2048 x 1536 pixels
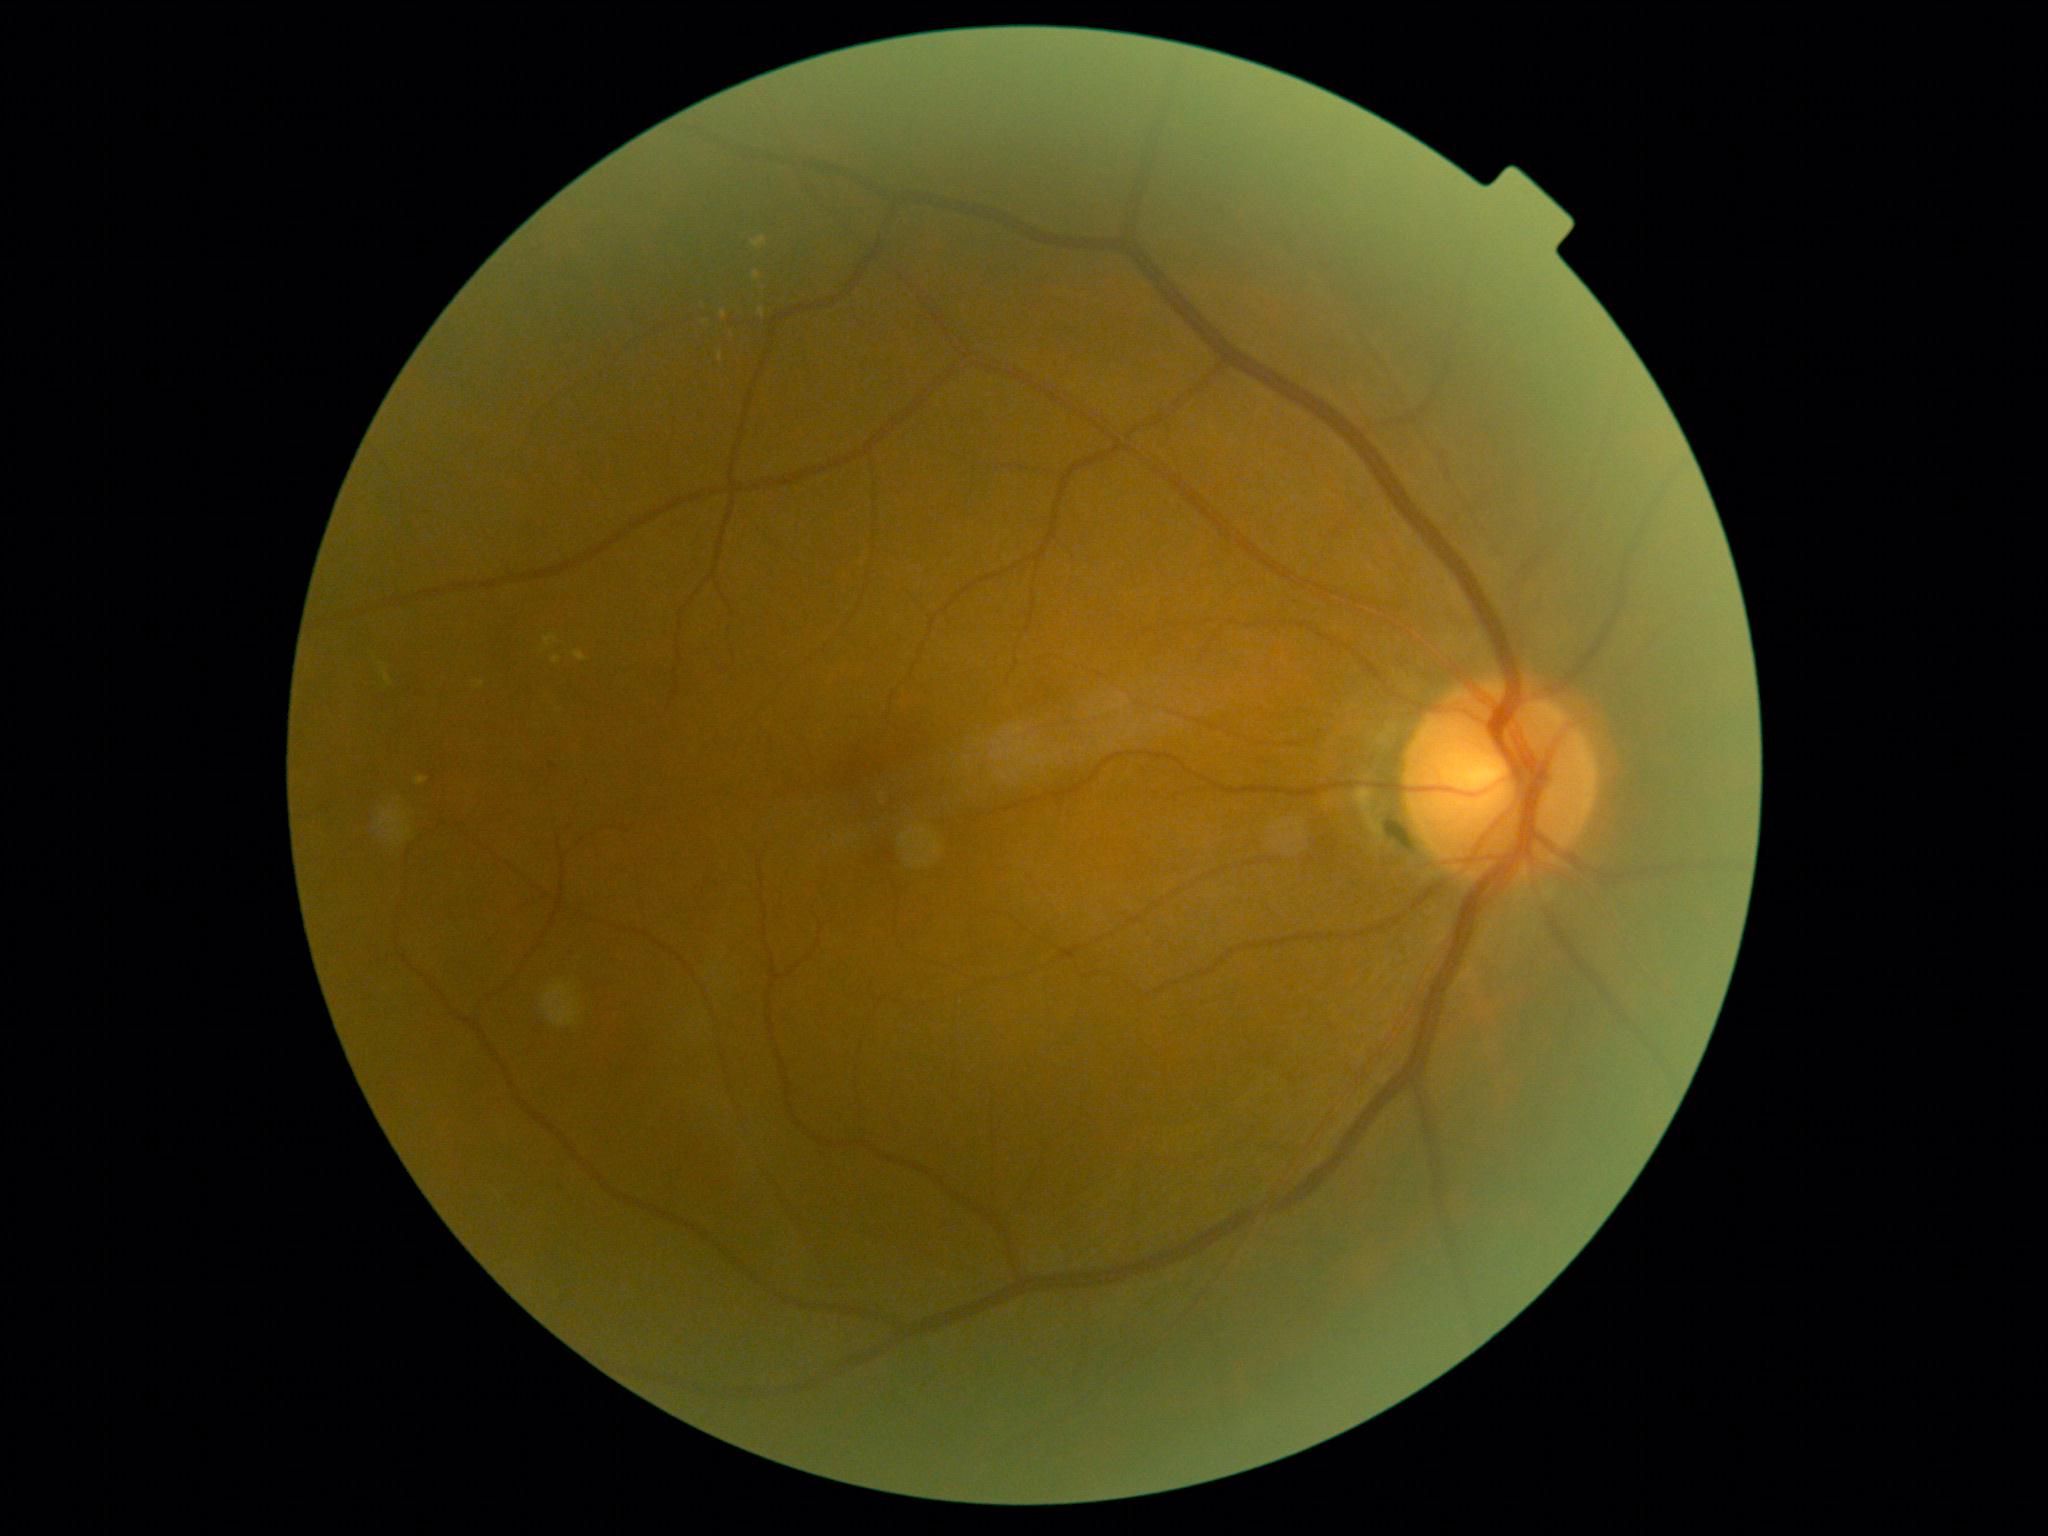

Diabetic retinopathy: grade 2 (moderate NPDR).